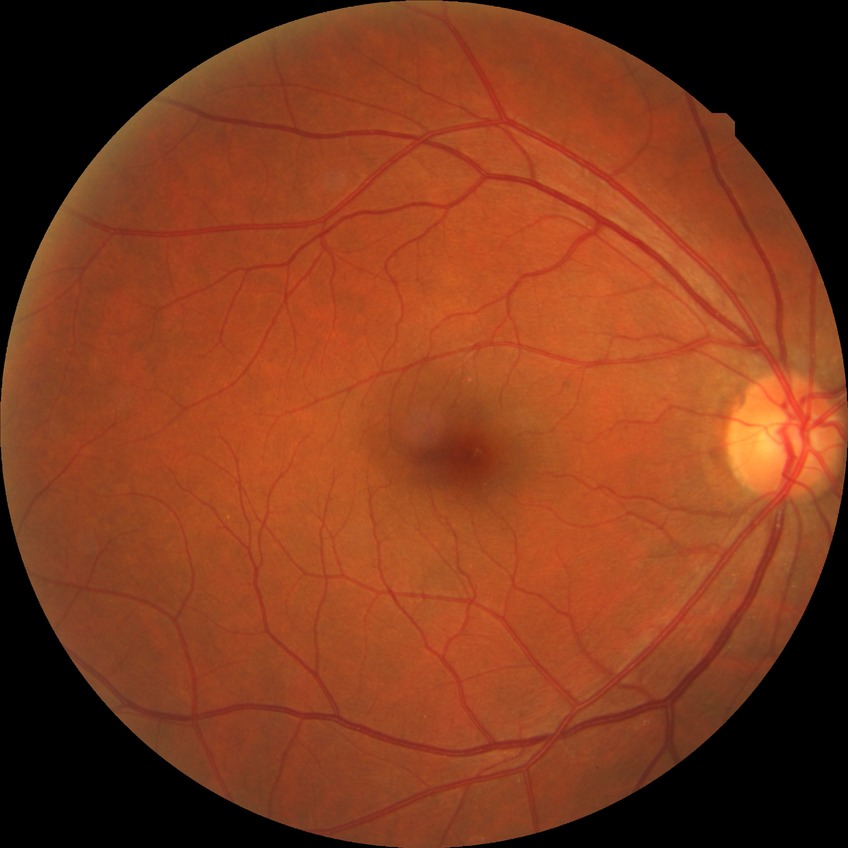
Diabetic retinopathy (DR) is NDR (no diabetic retinopathy).